2102x1736 · retinal fundus photograph
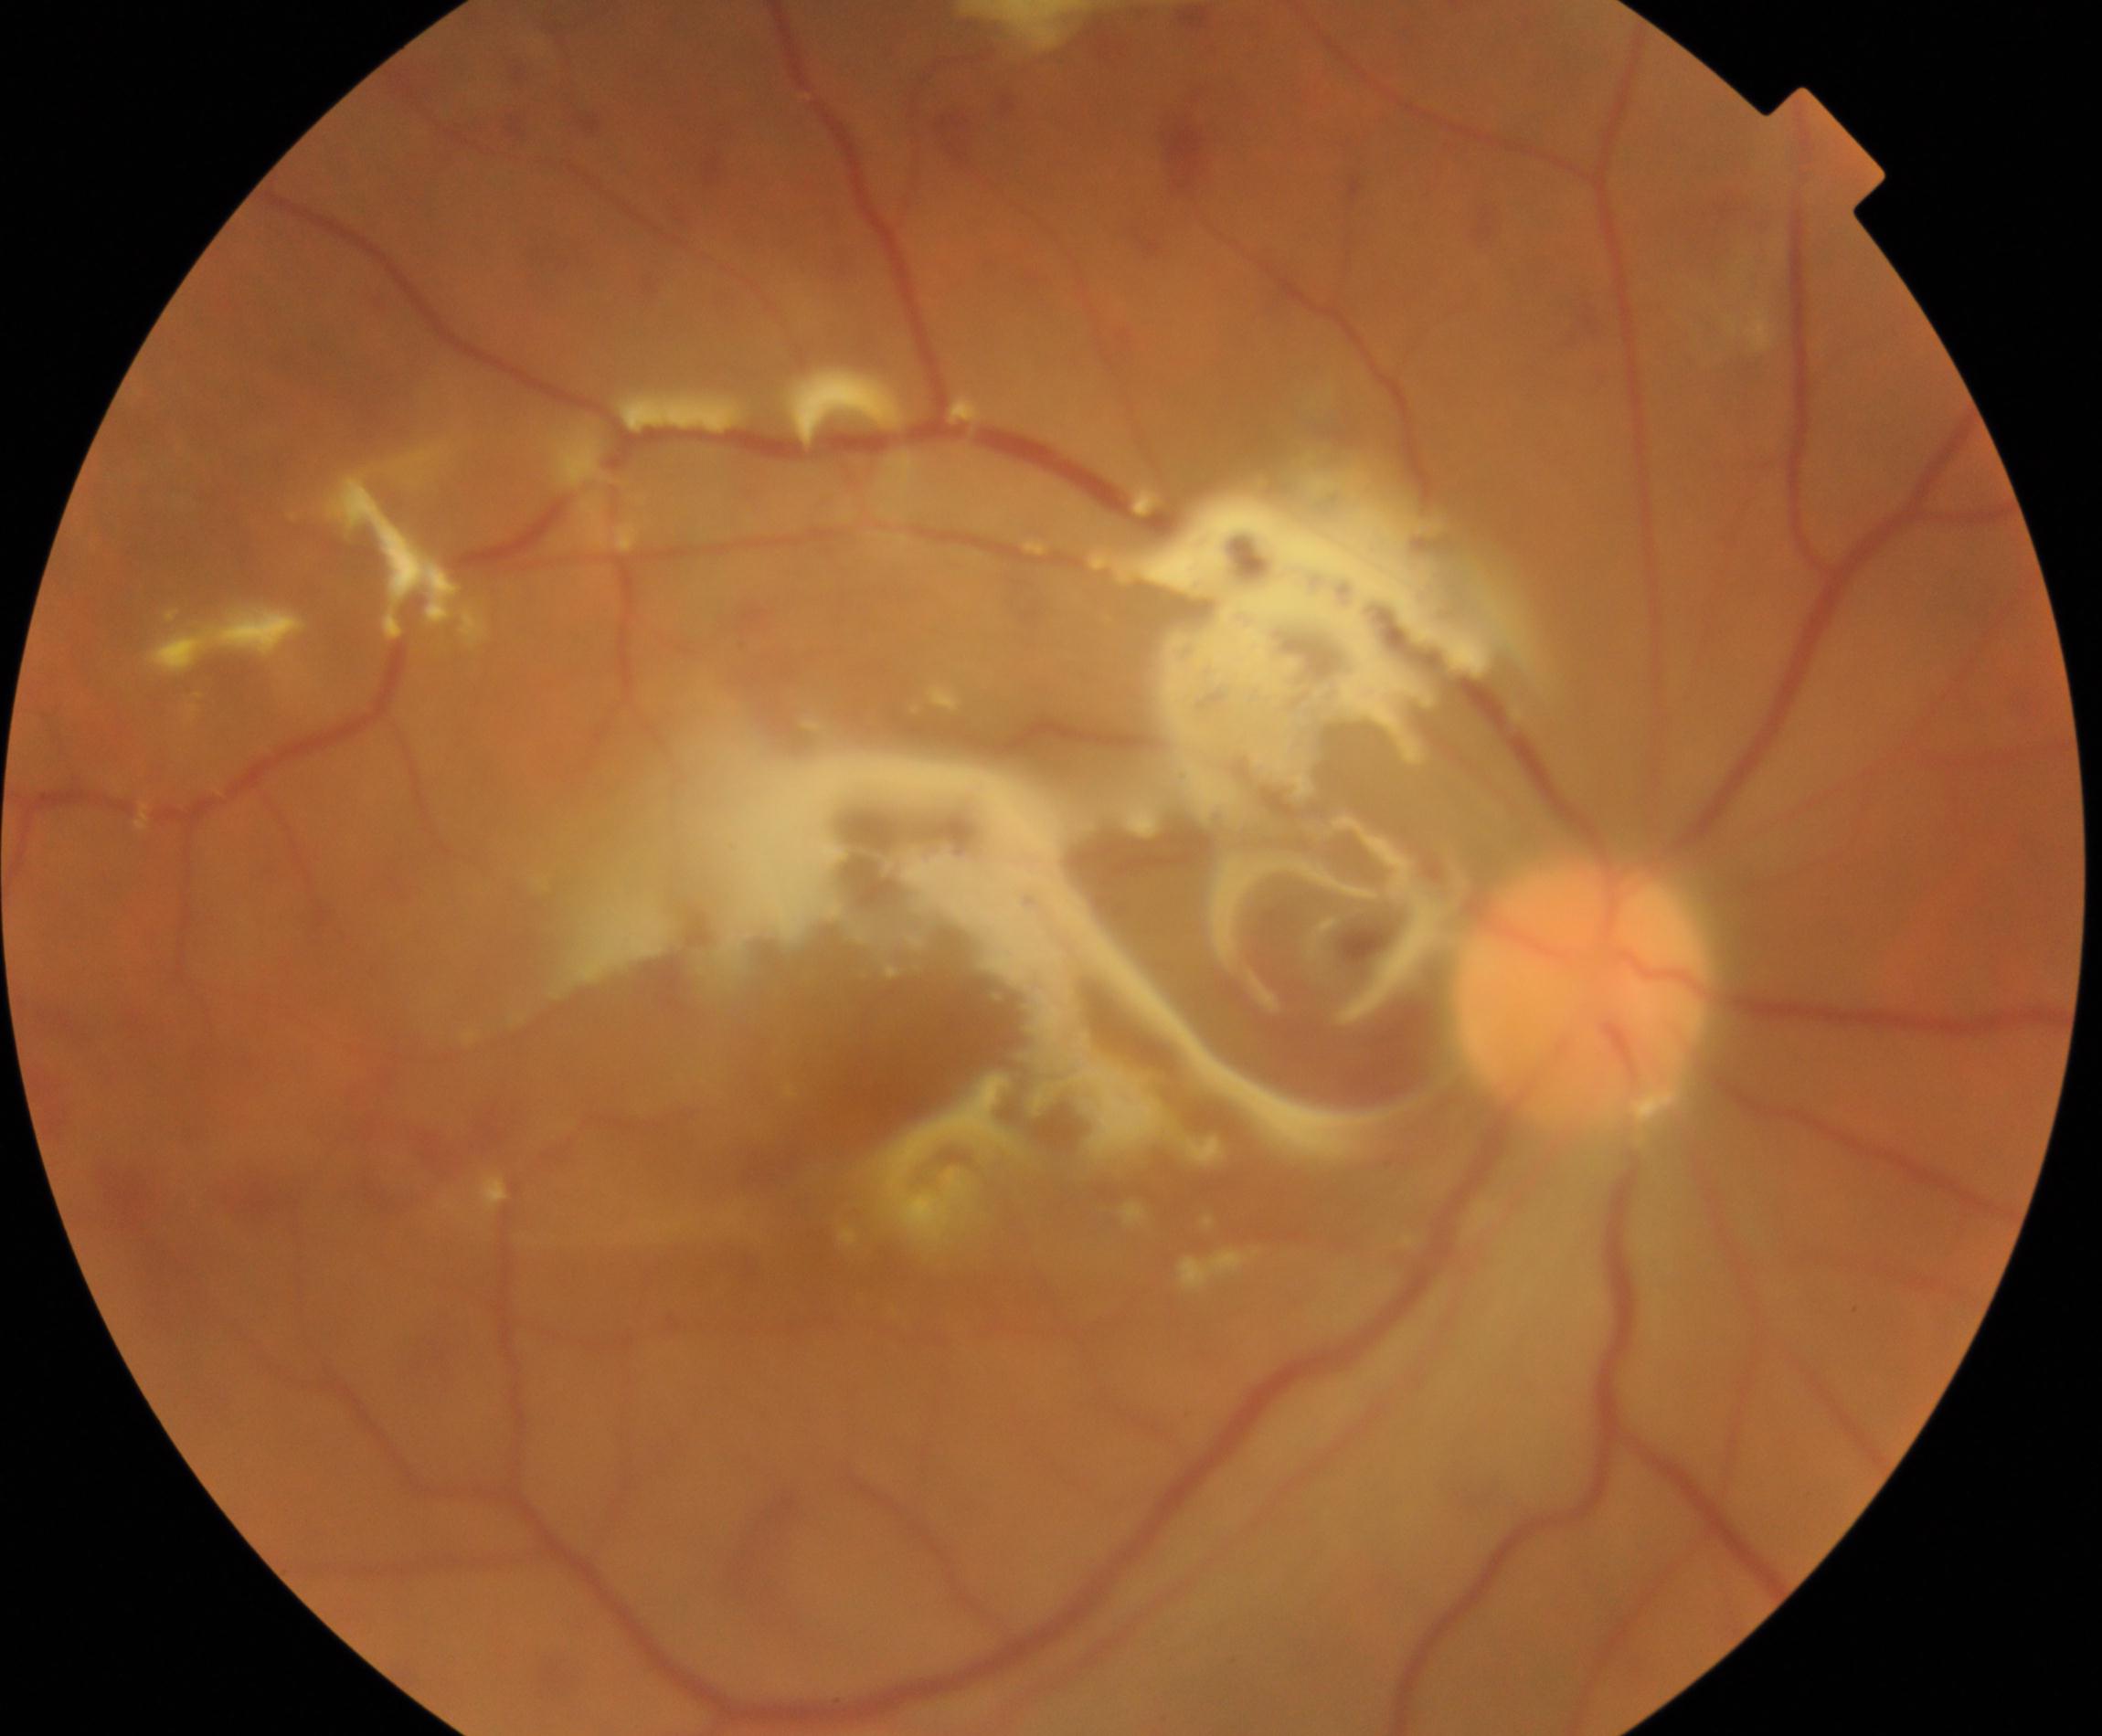
Treatment history: silicone oil in the eye.